45° FOV: 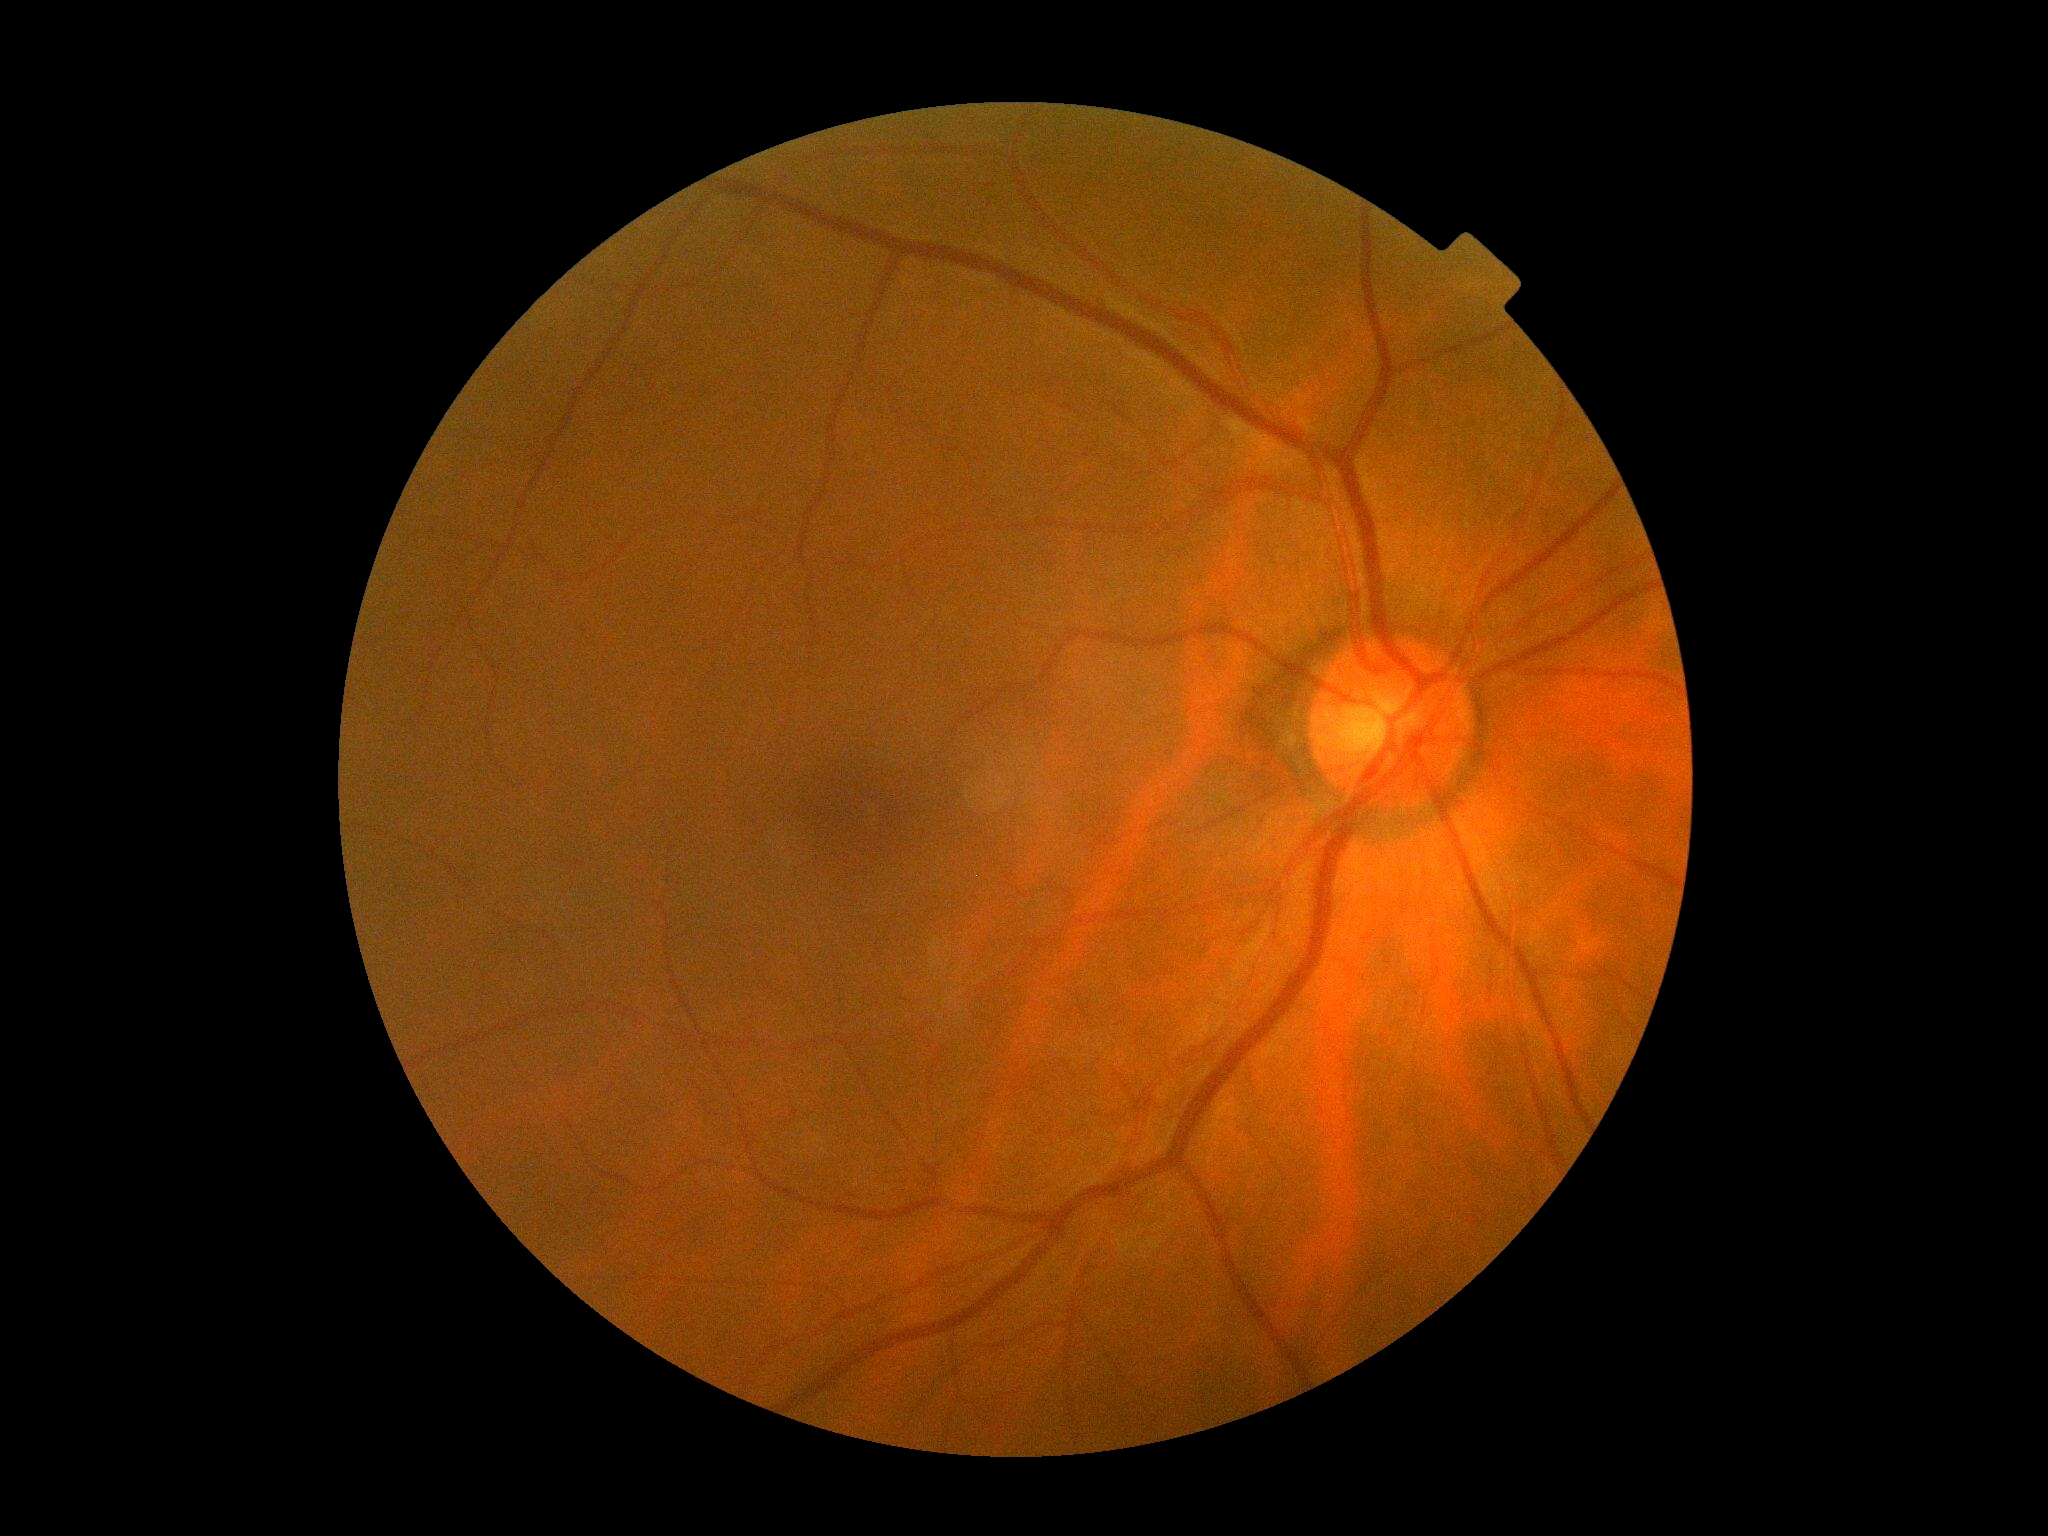
– DR grade: no apparent retinopathy (0)